CFP.
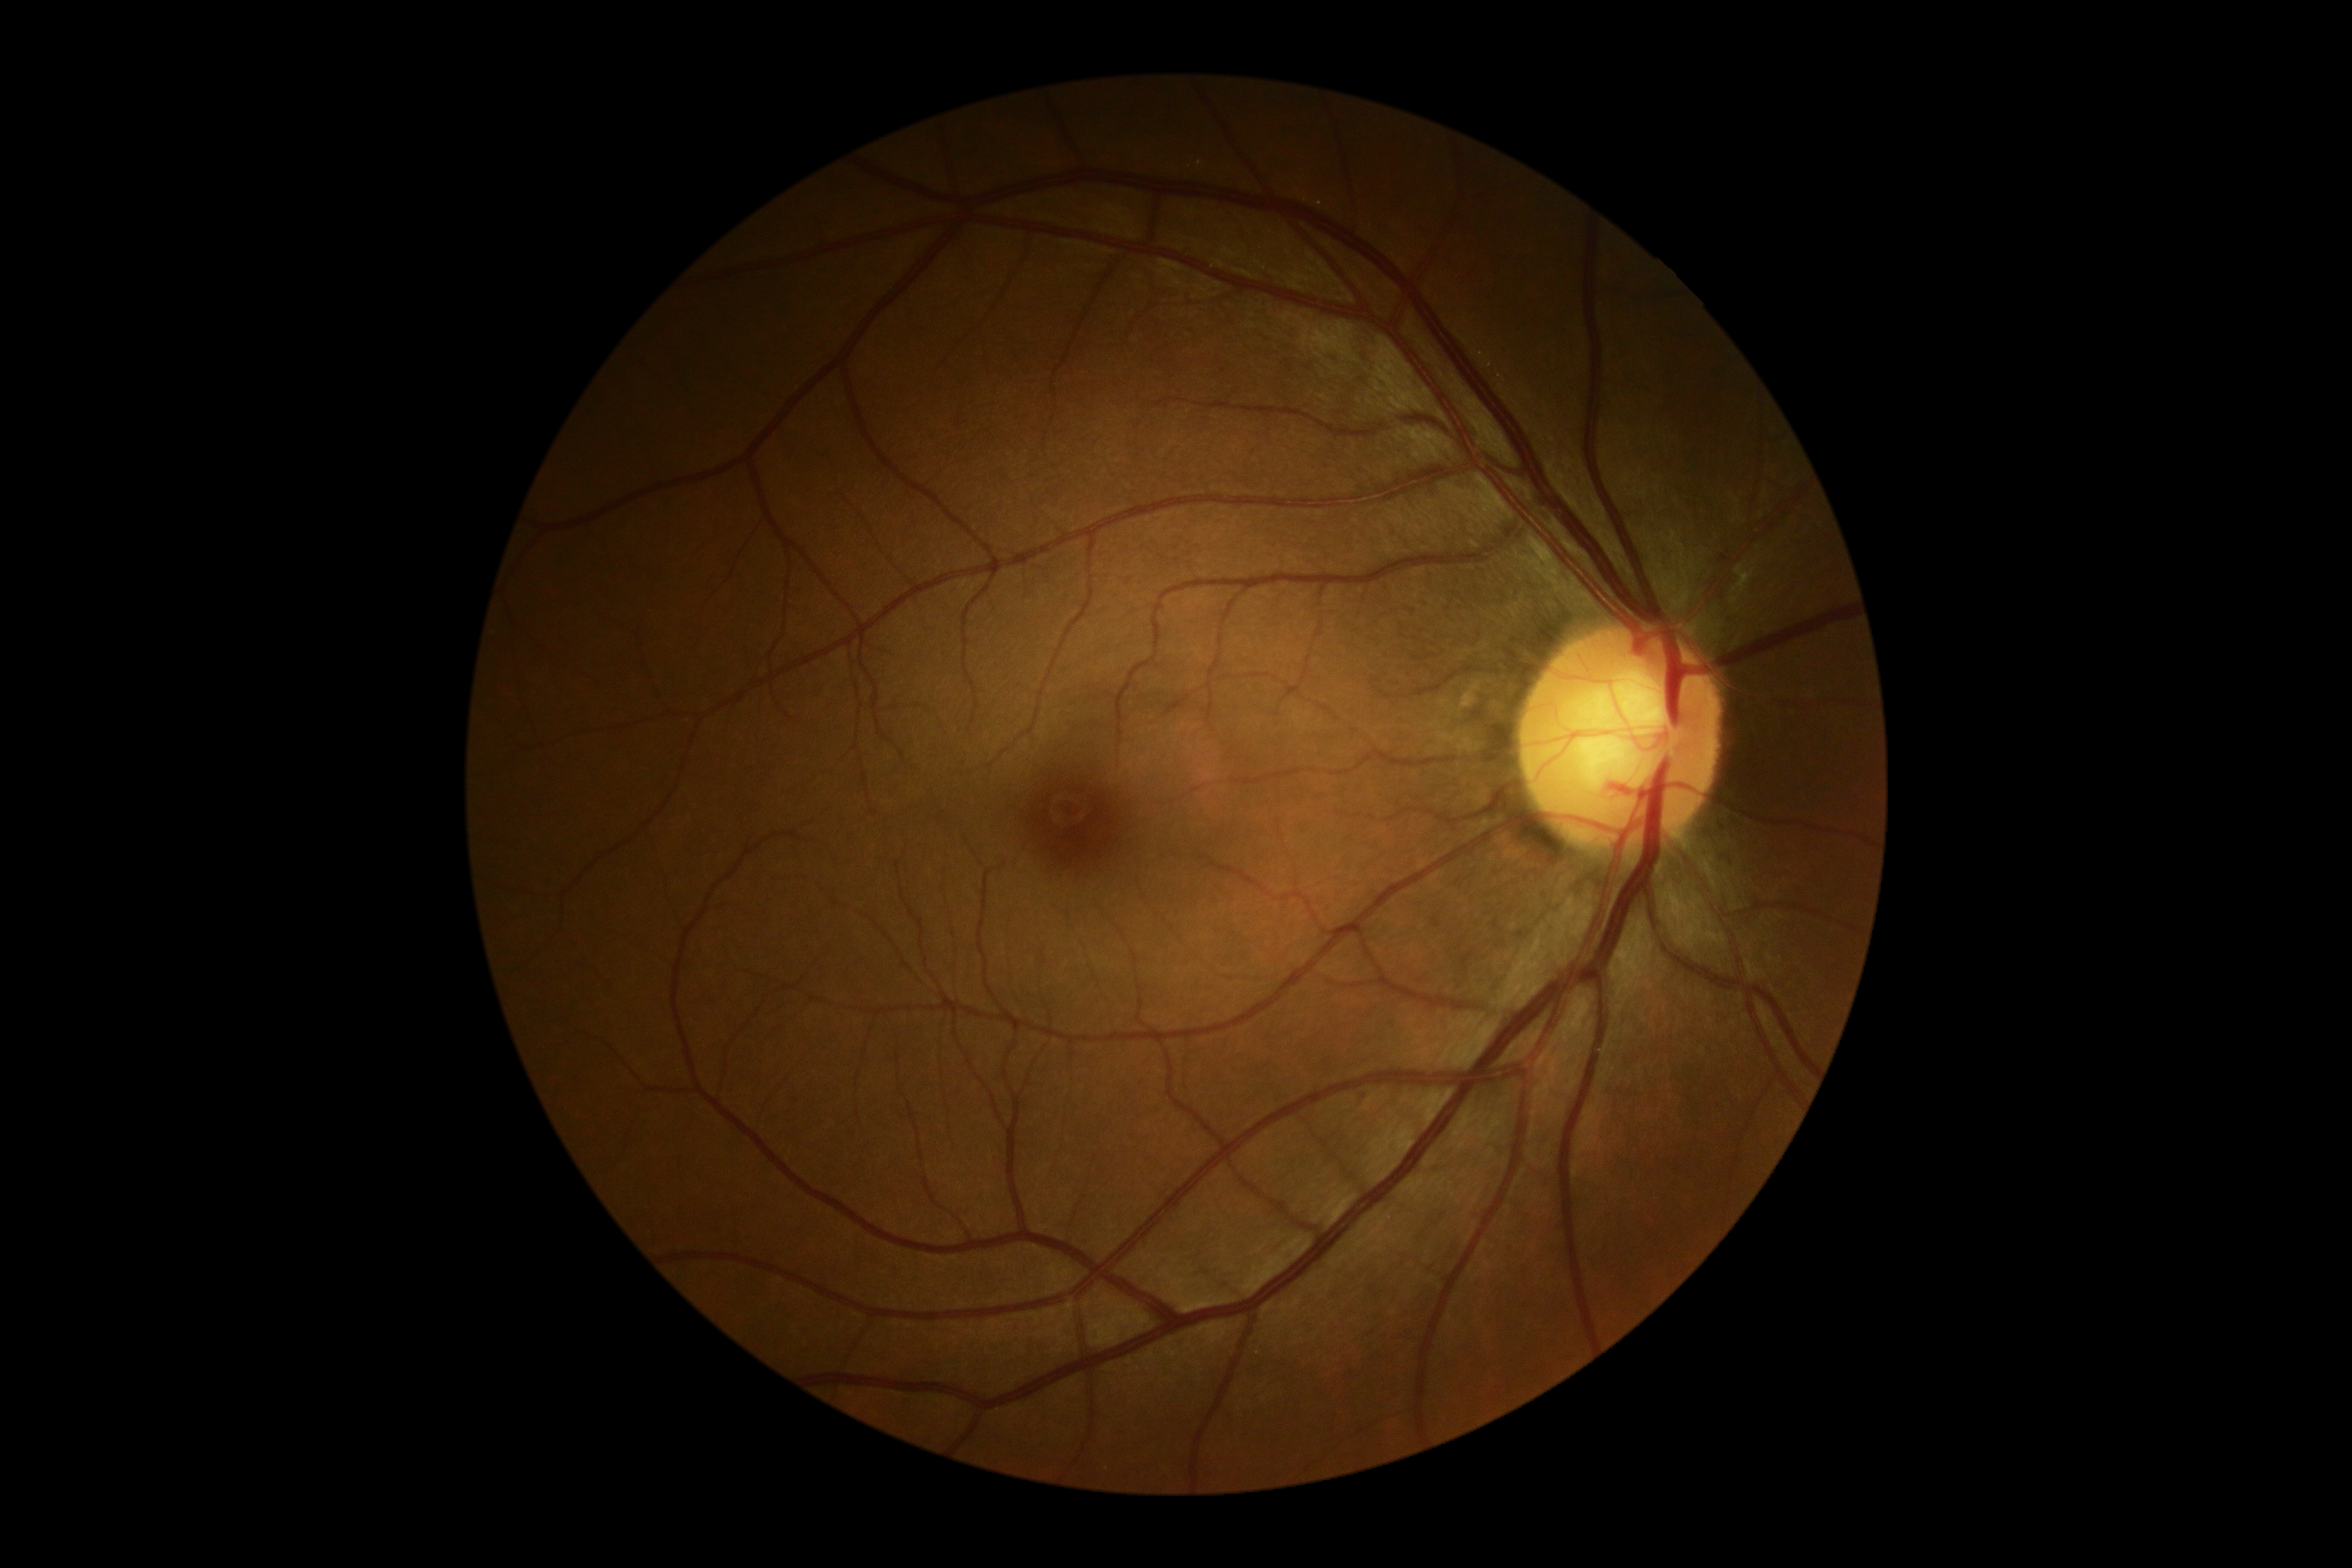 diabetic retinopathy (DR)=no apparent retinopathy (grade 0).